Graded on the modified Davis scale: 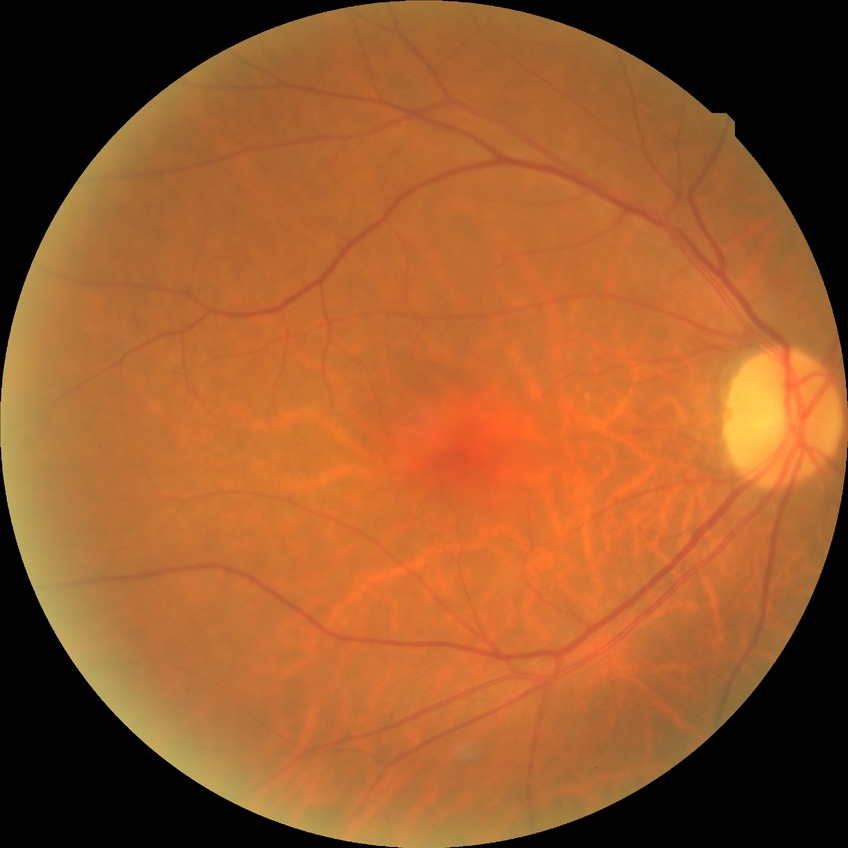

DR grade: NDR.